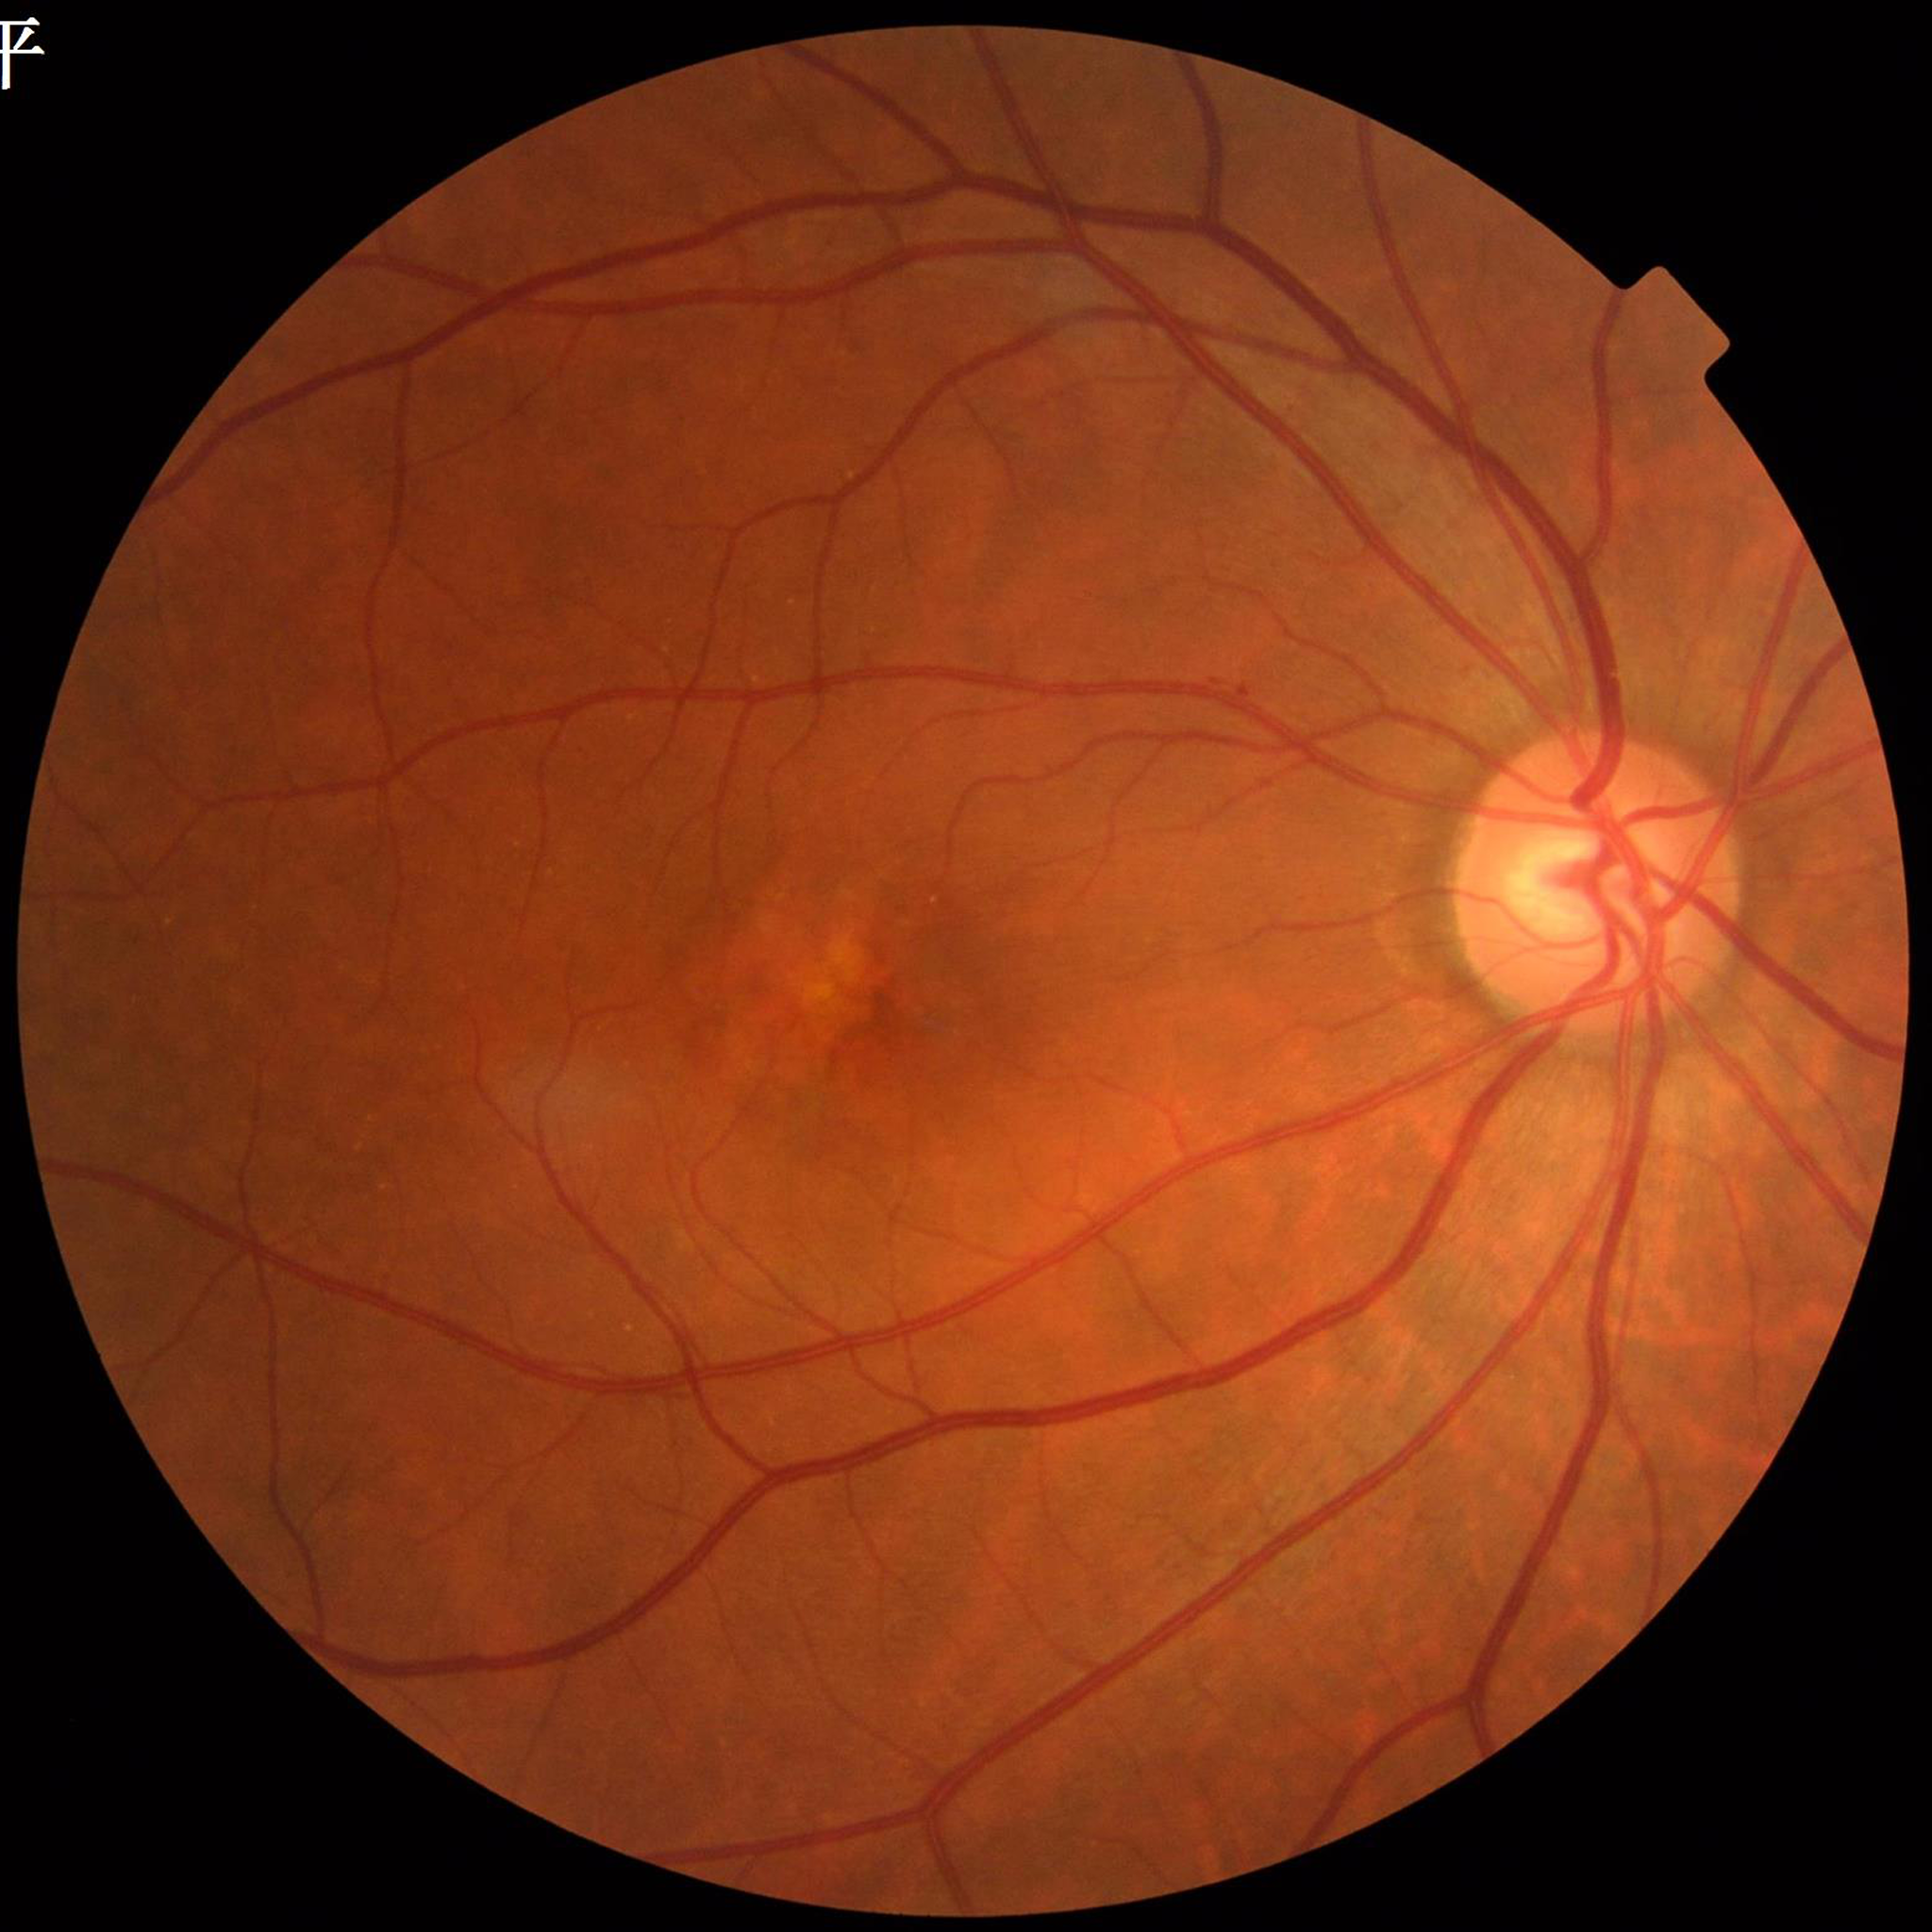 Fundus image of an eye with AMD.
Quality assessment: satisfactory.